Image size 2048x1536; 45° FOV.
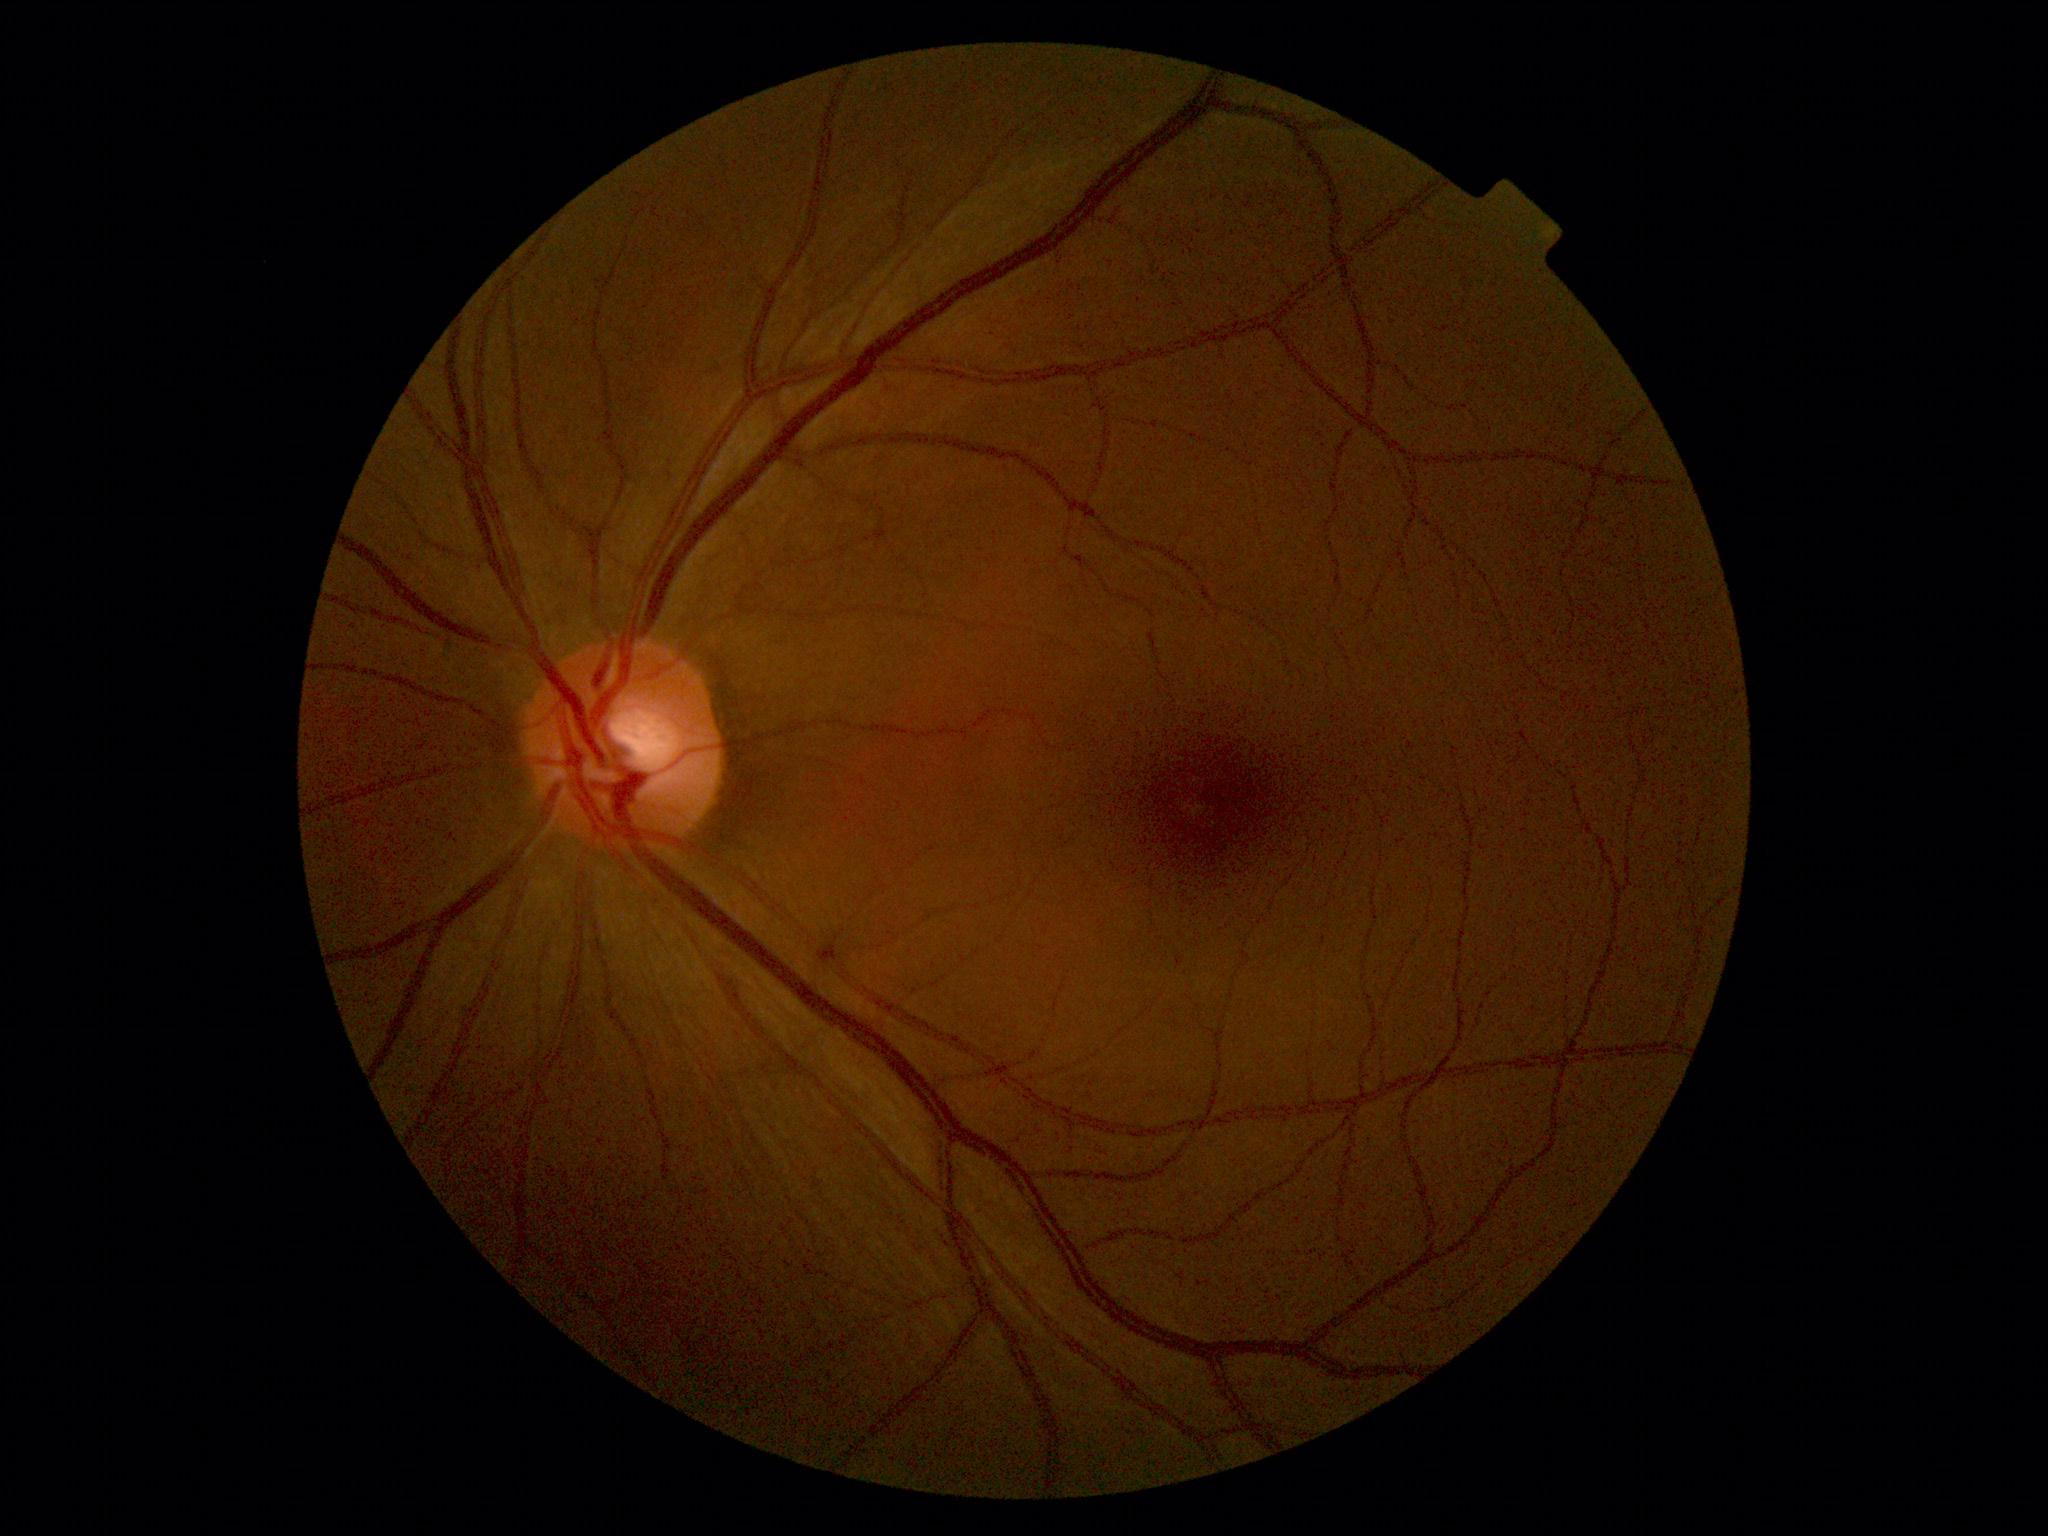
DR stage = 0.